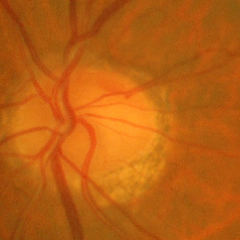 Showing no signs of glaucoma.